2212 by 1659 pixels · 45-degree field of view
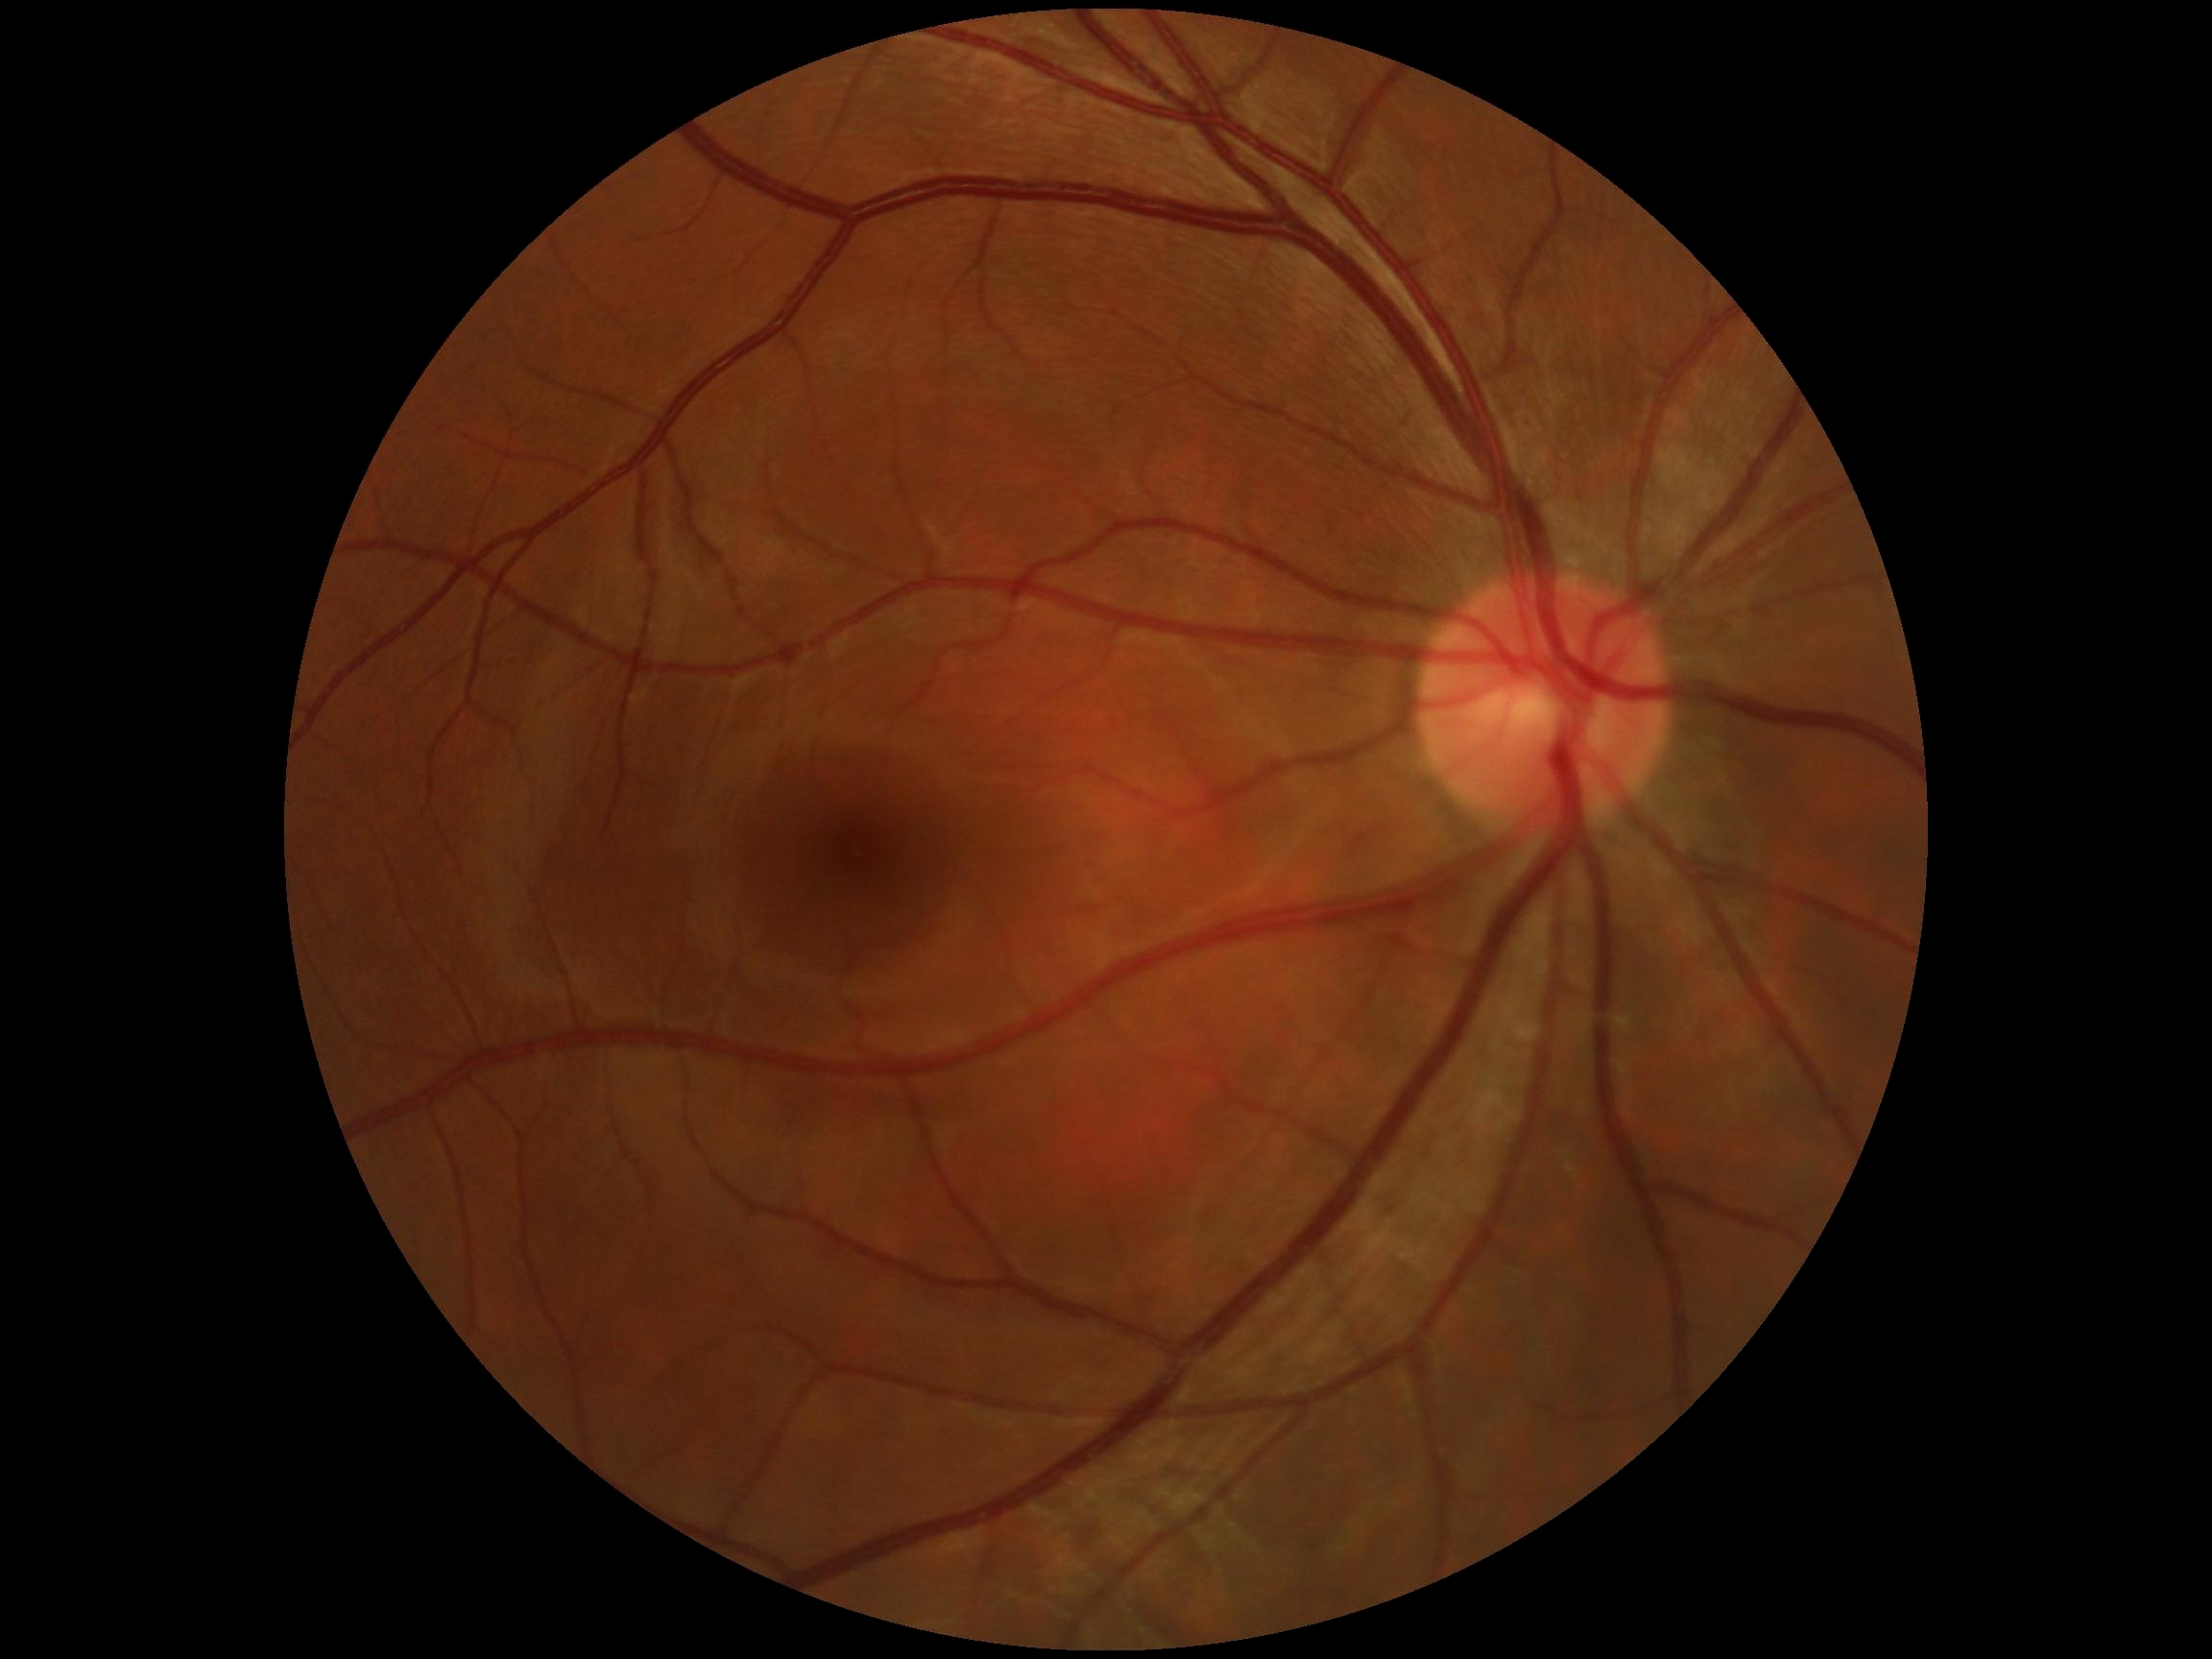 Diabetic retinopathy (DR) is grade 0 (no apparent retinopathy).